DR severity per modified Davis staging. 45 degree fundus photograph
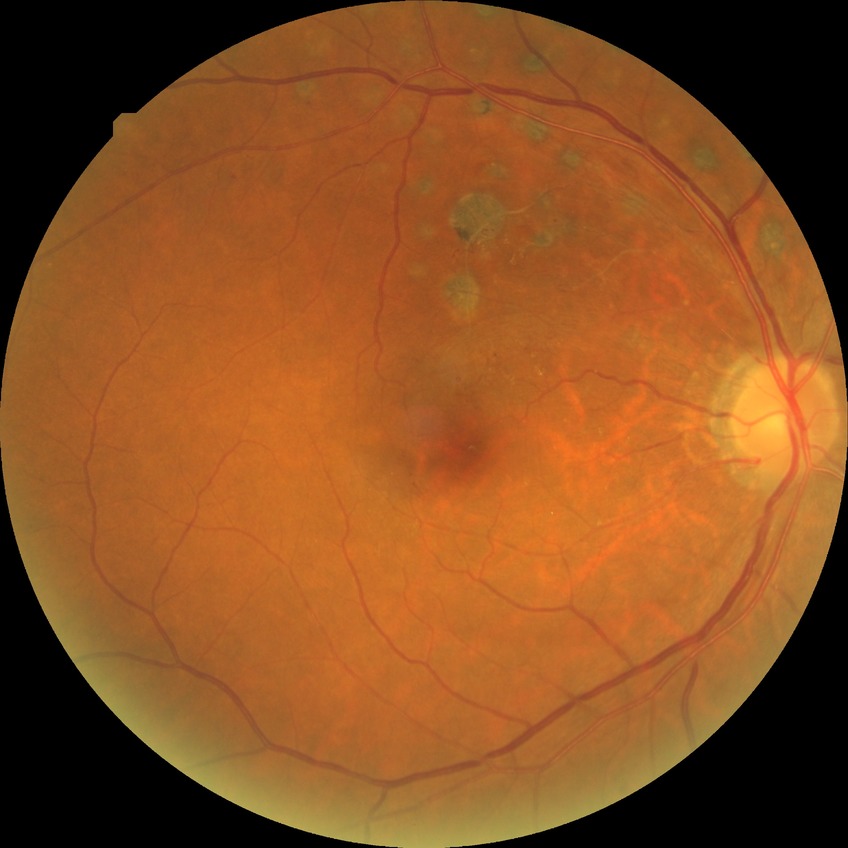

Modified Davis grading: simple diabetic retinopathy.